Posterior pole field covering the optic disc and macula. Image size 2228x1652. Pupil-dilated — 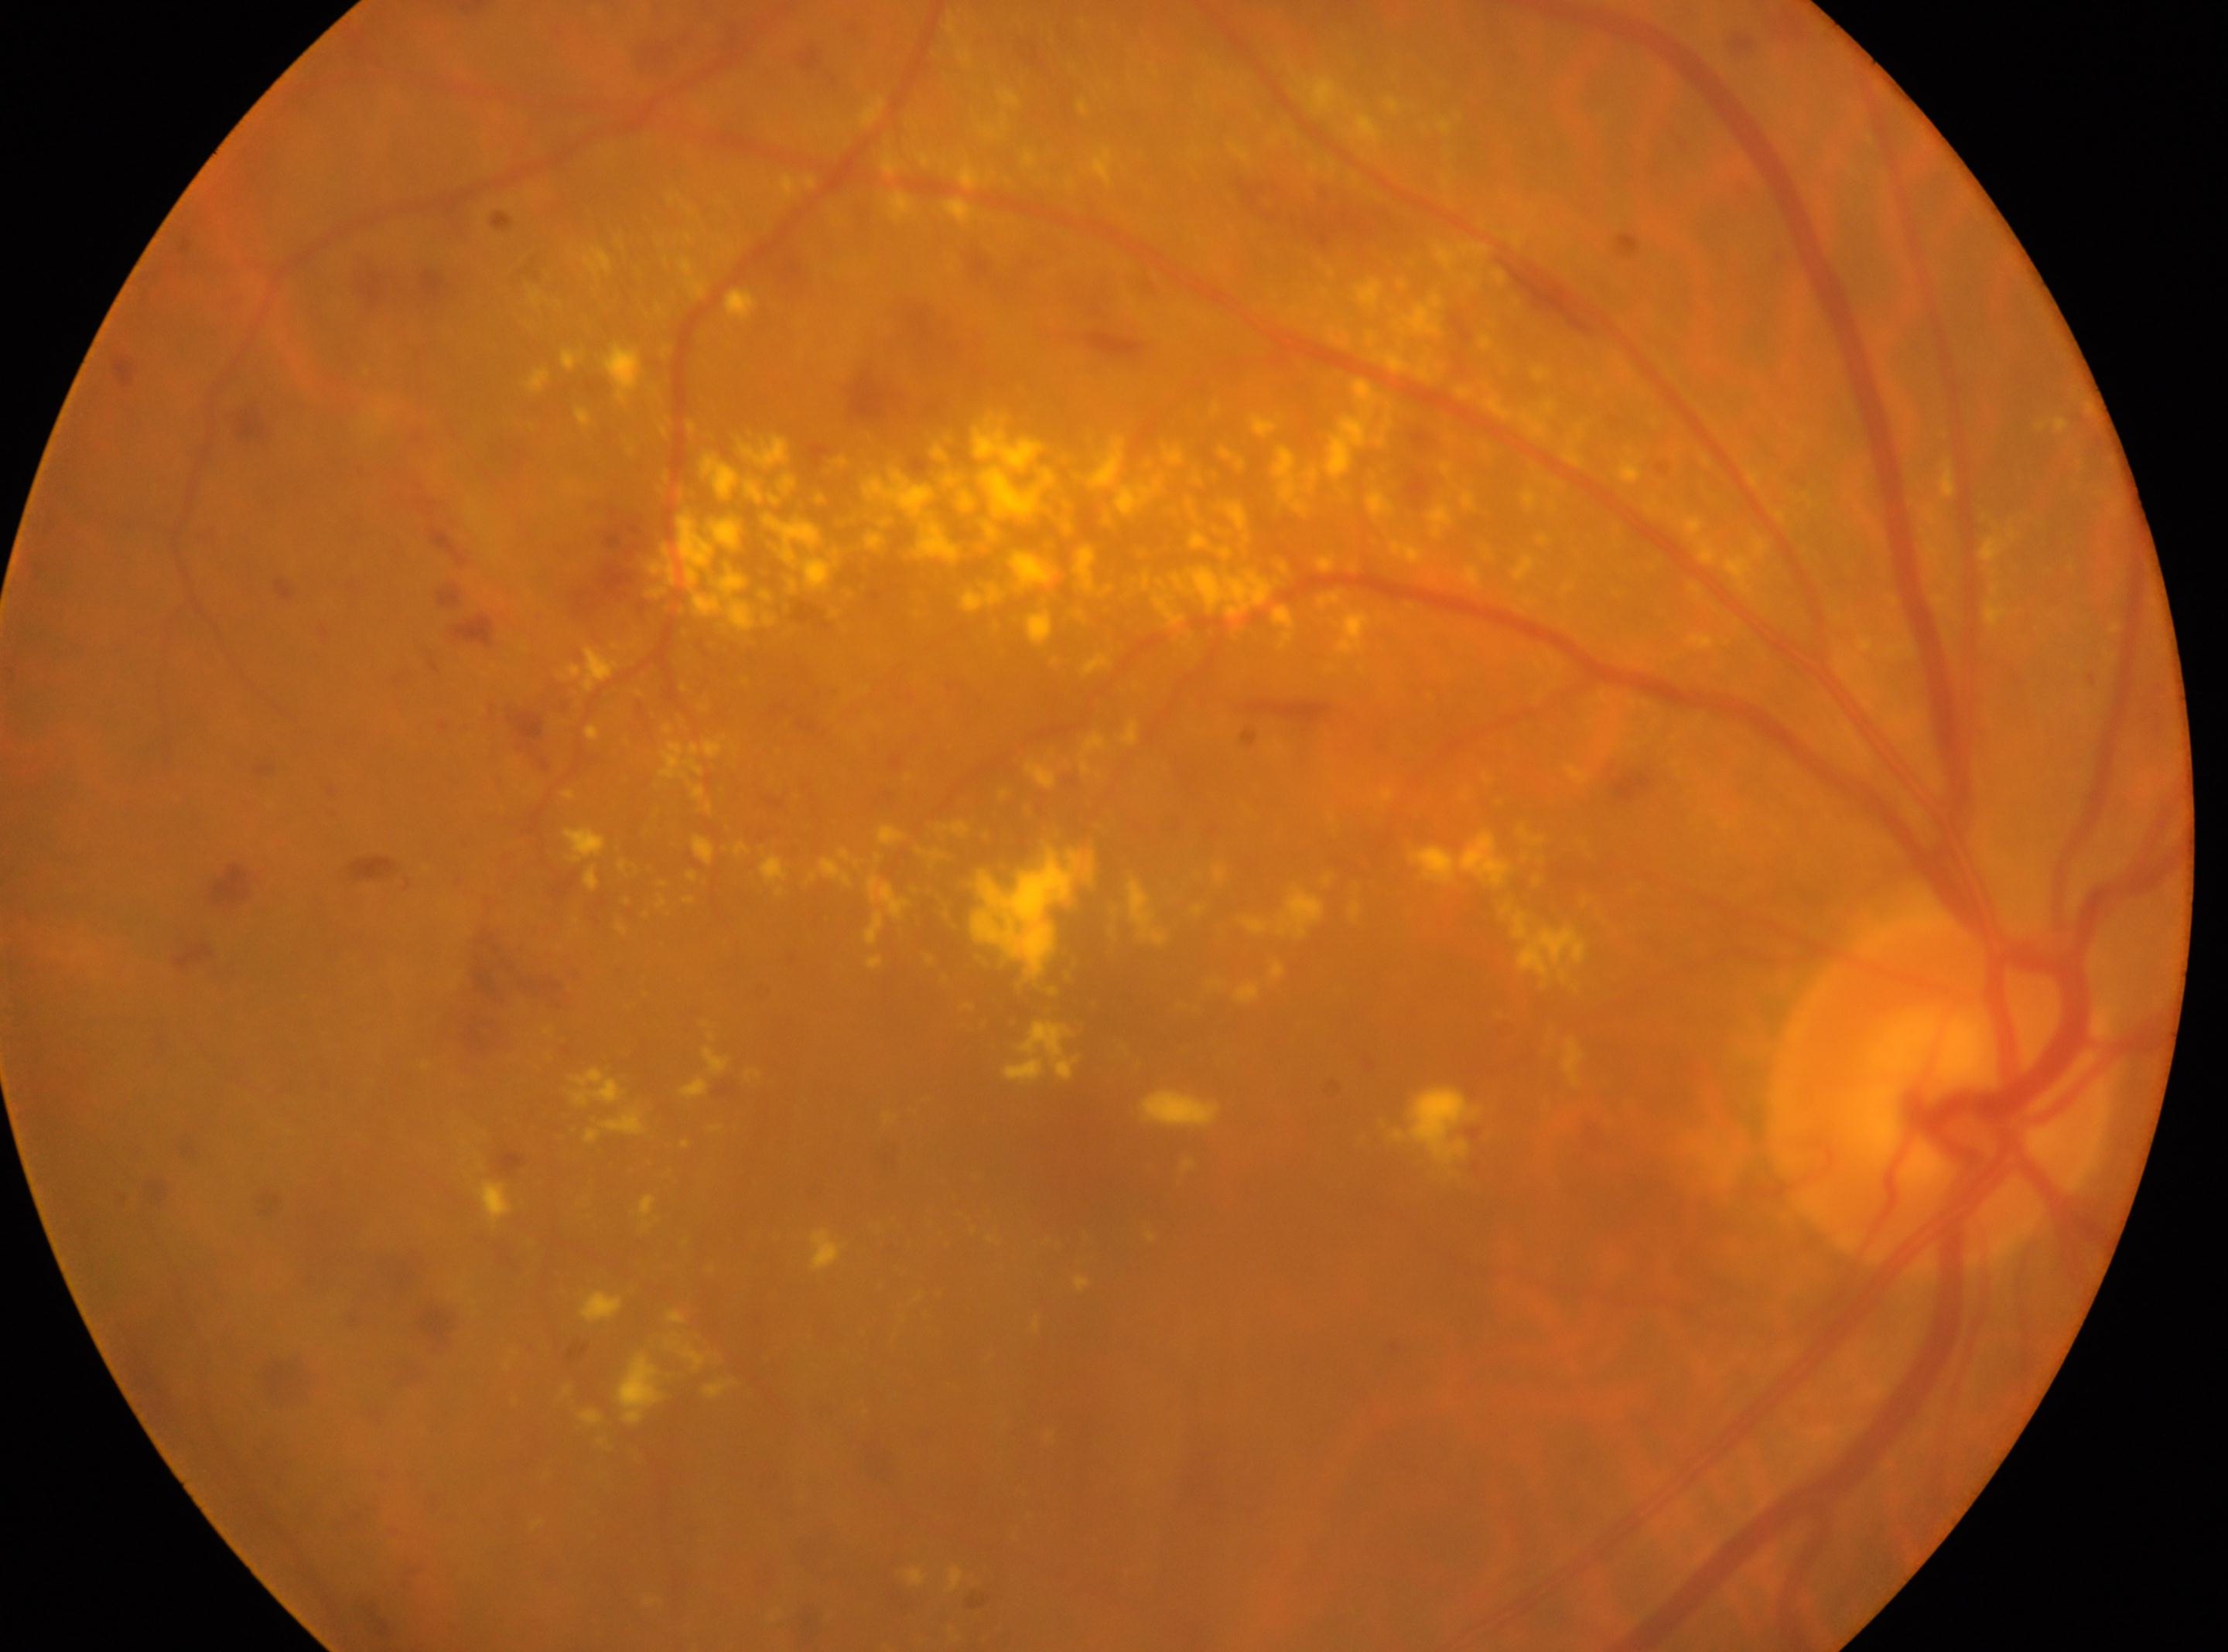 Fovea centralis located at (x: 1077, y: 1142). The image shows the oculus dexter. DR stage: 3. The disc center is at (x: 1939, y: 1090).